Color fundus photograph
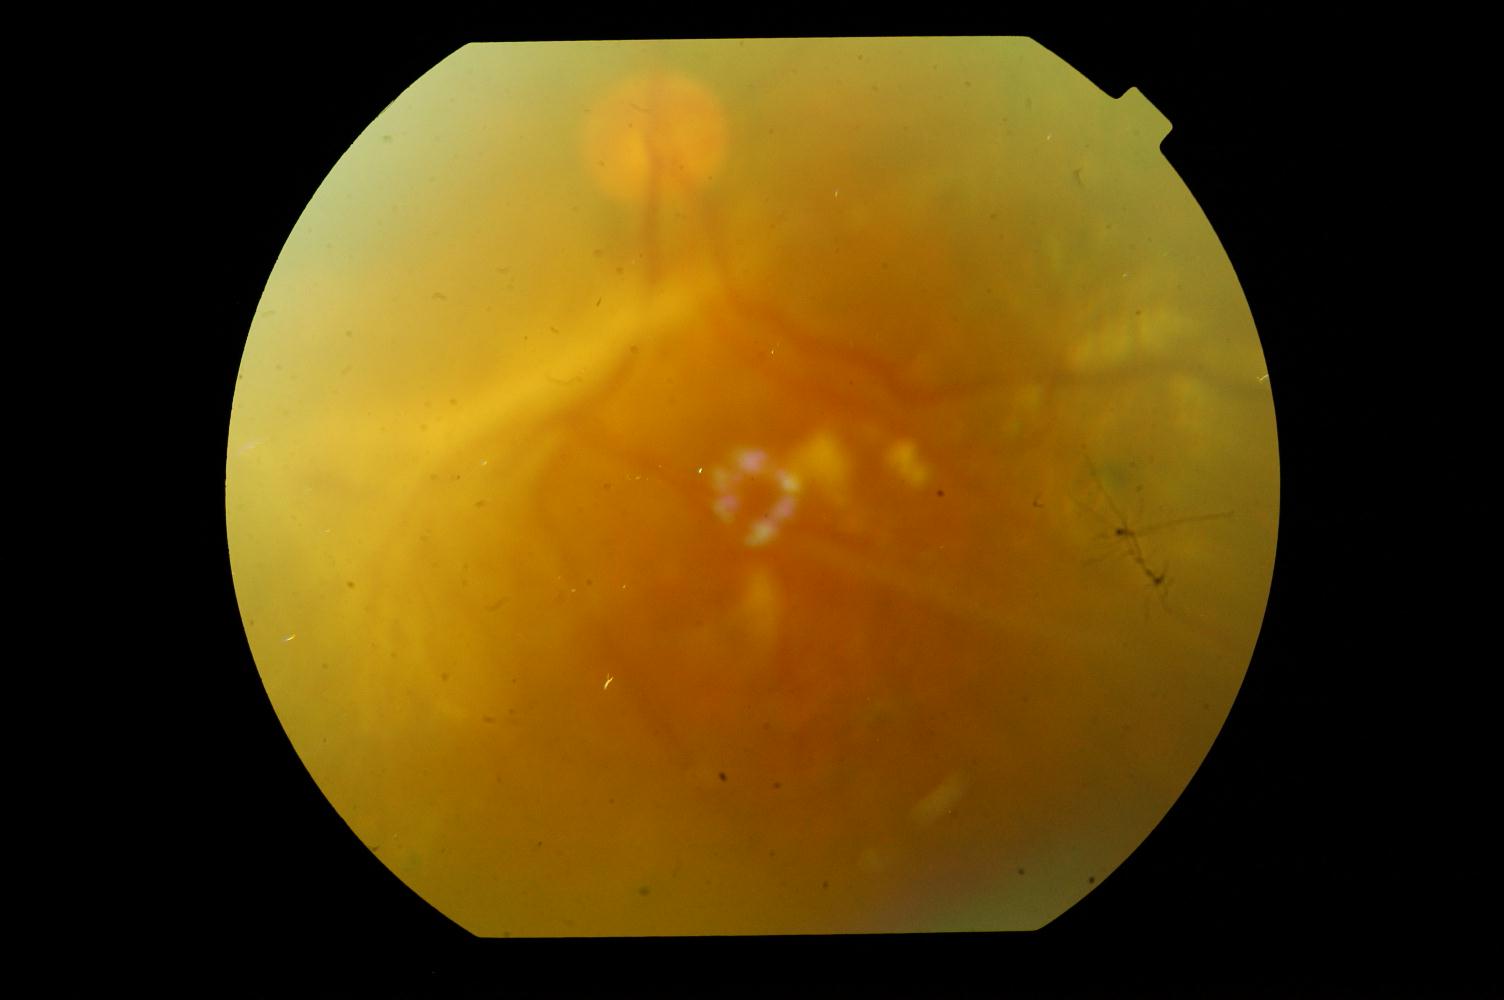

Demonstrates diabetic retinopathy (DR).